Wide-field contact fundus photograph of an infant
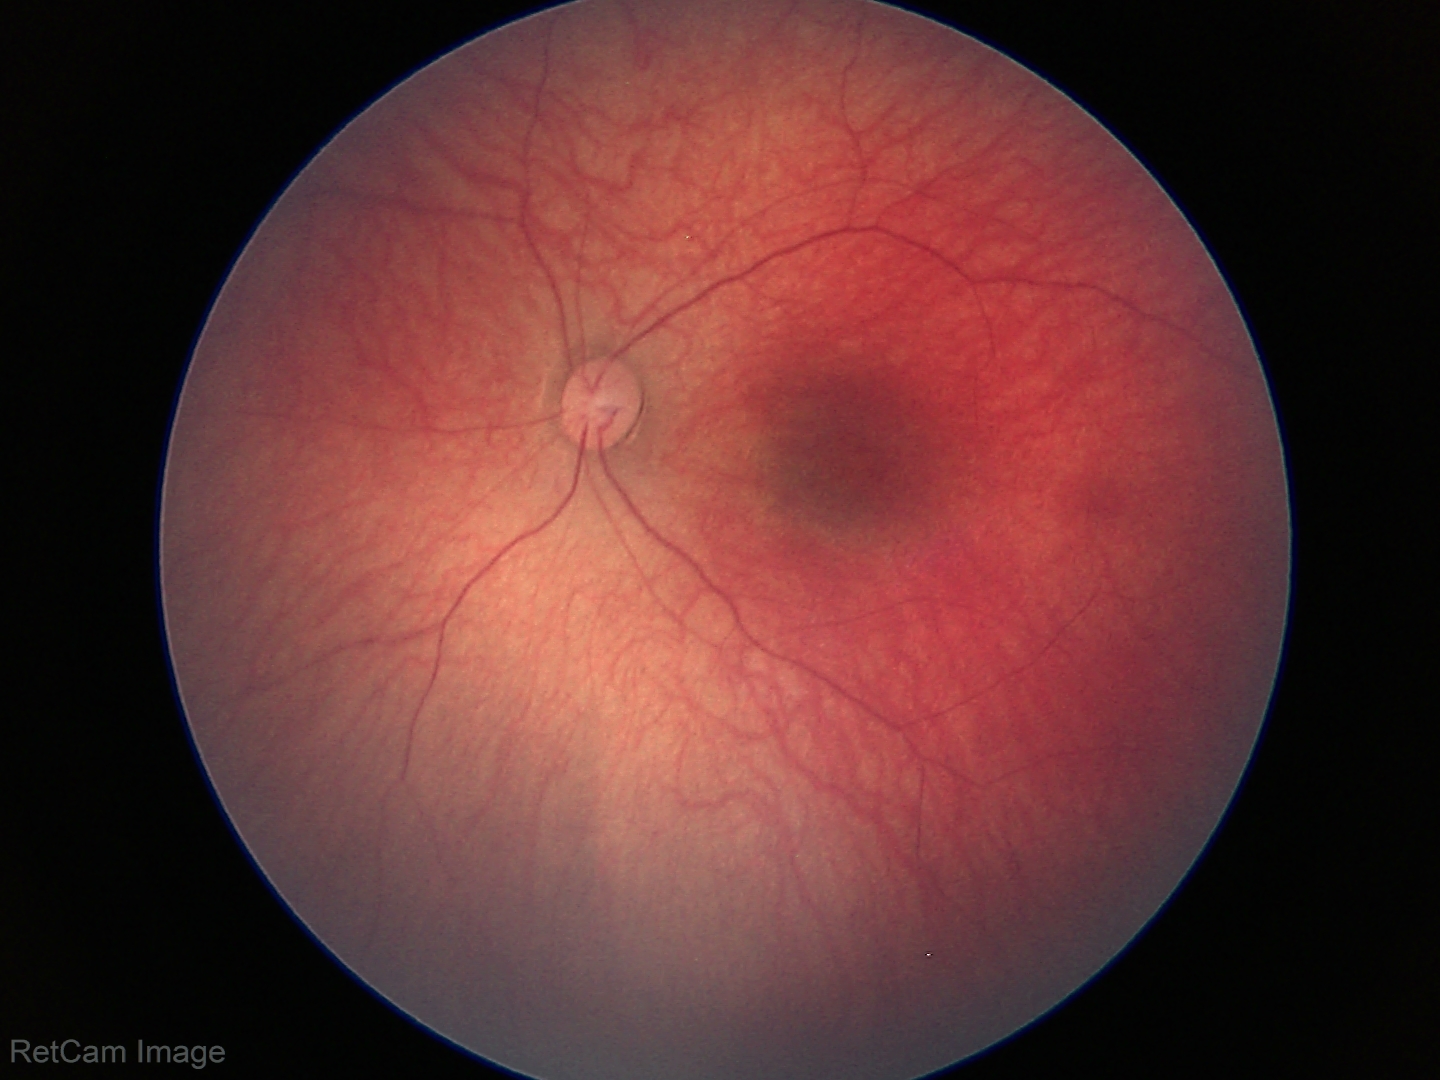
Screening examination with no abnormal retinal findings.